45-degree field of view; nonmydriatic fundus photograph; image size 848x848.
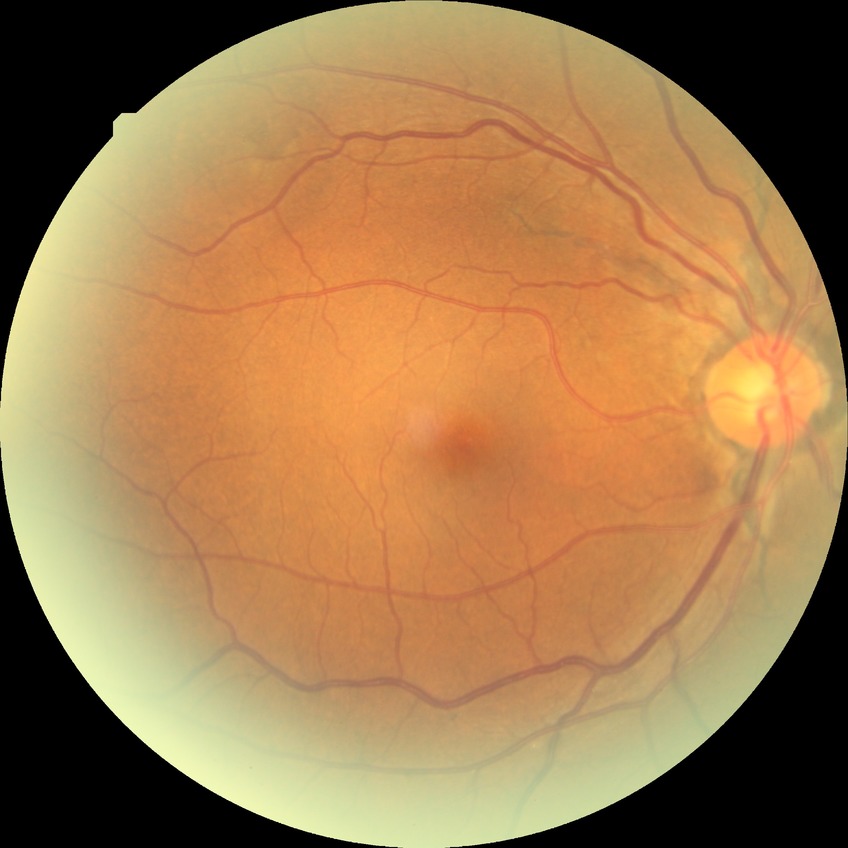

Davis stage = NDR.